2212x1659. 45-degree field of view. Fundus photo
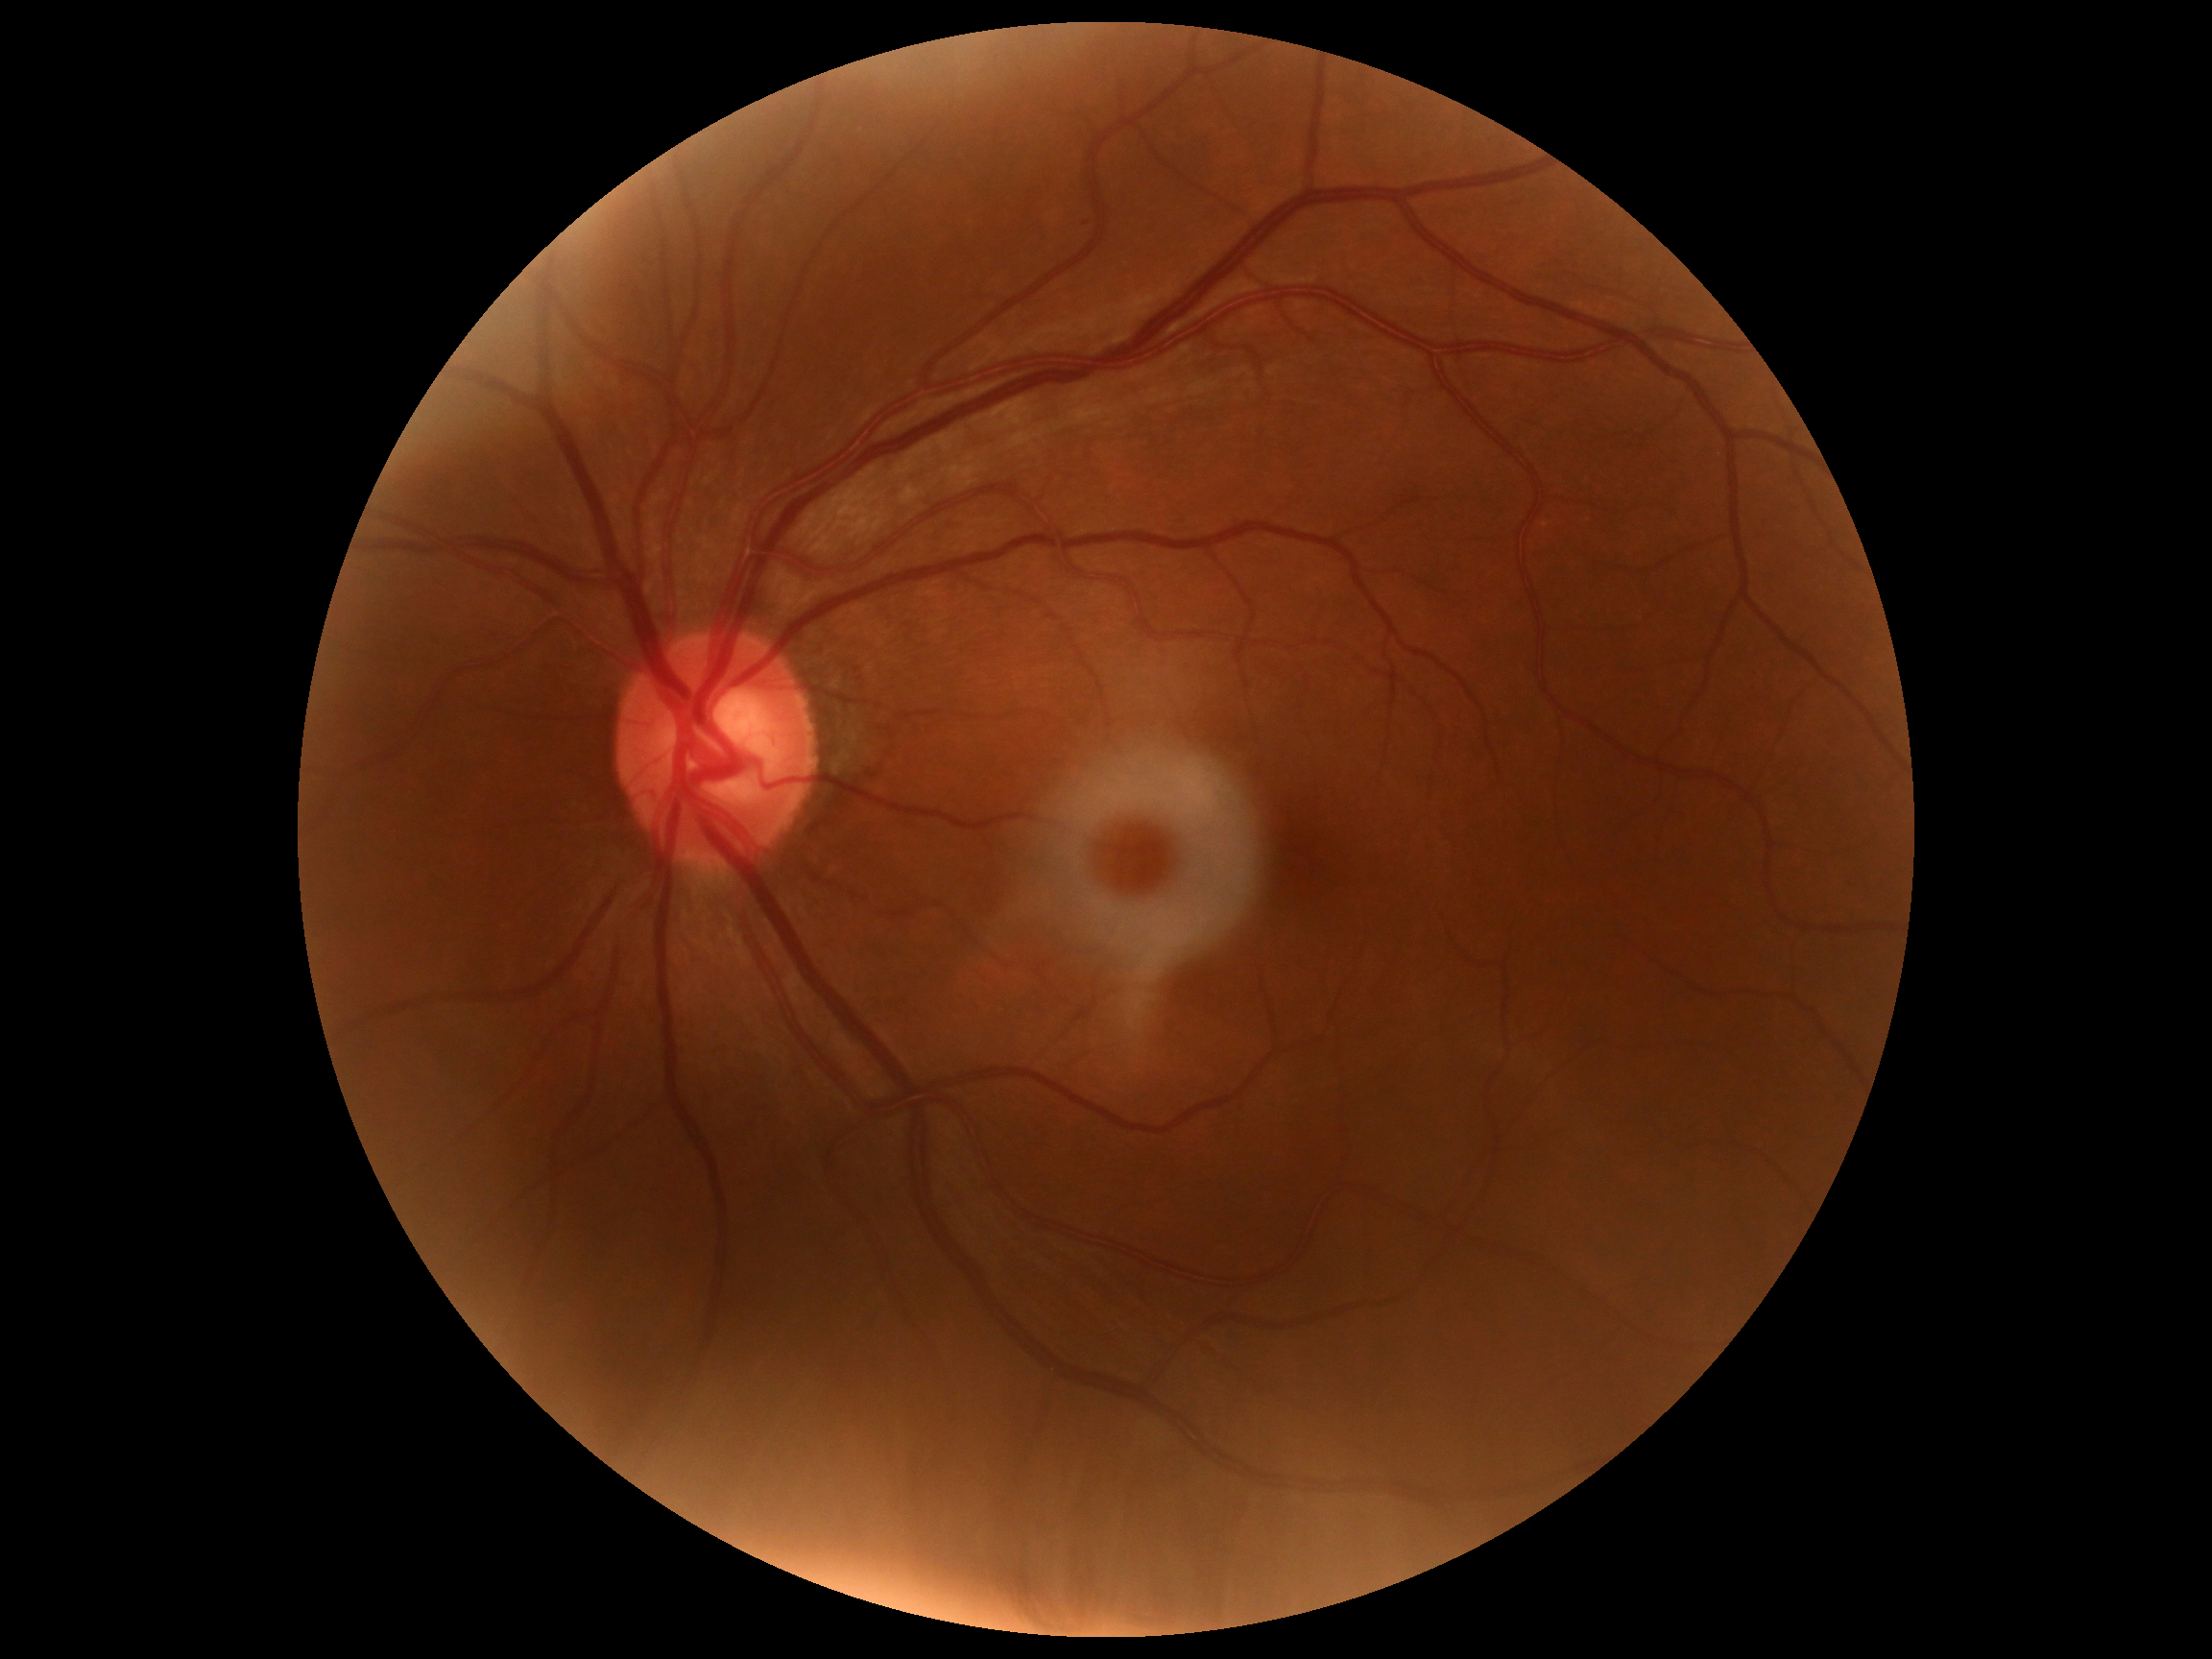 Findings:
* retinopathy grade — no apparent diabetic retinopathy (0)
* DR impression — no apparent DR